Modified Davis grading: 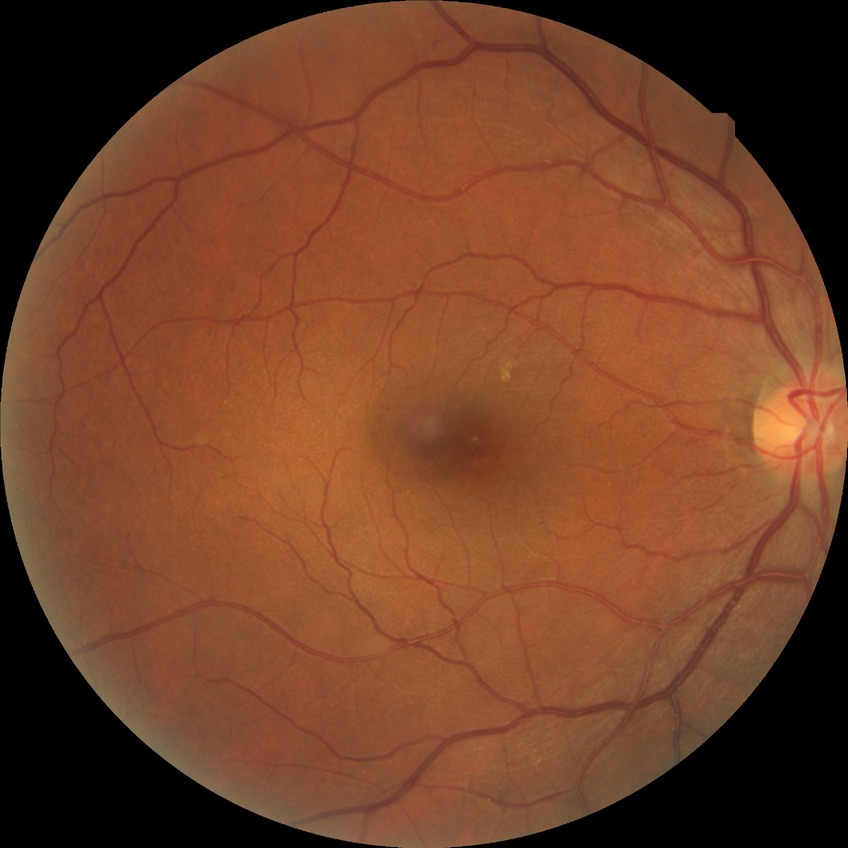

diabetic retinopathy (DR)@NDR (no diabetic retinopathy).